Retinal fundus photograph.
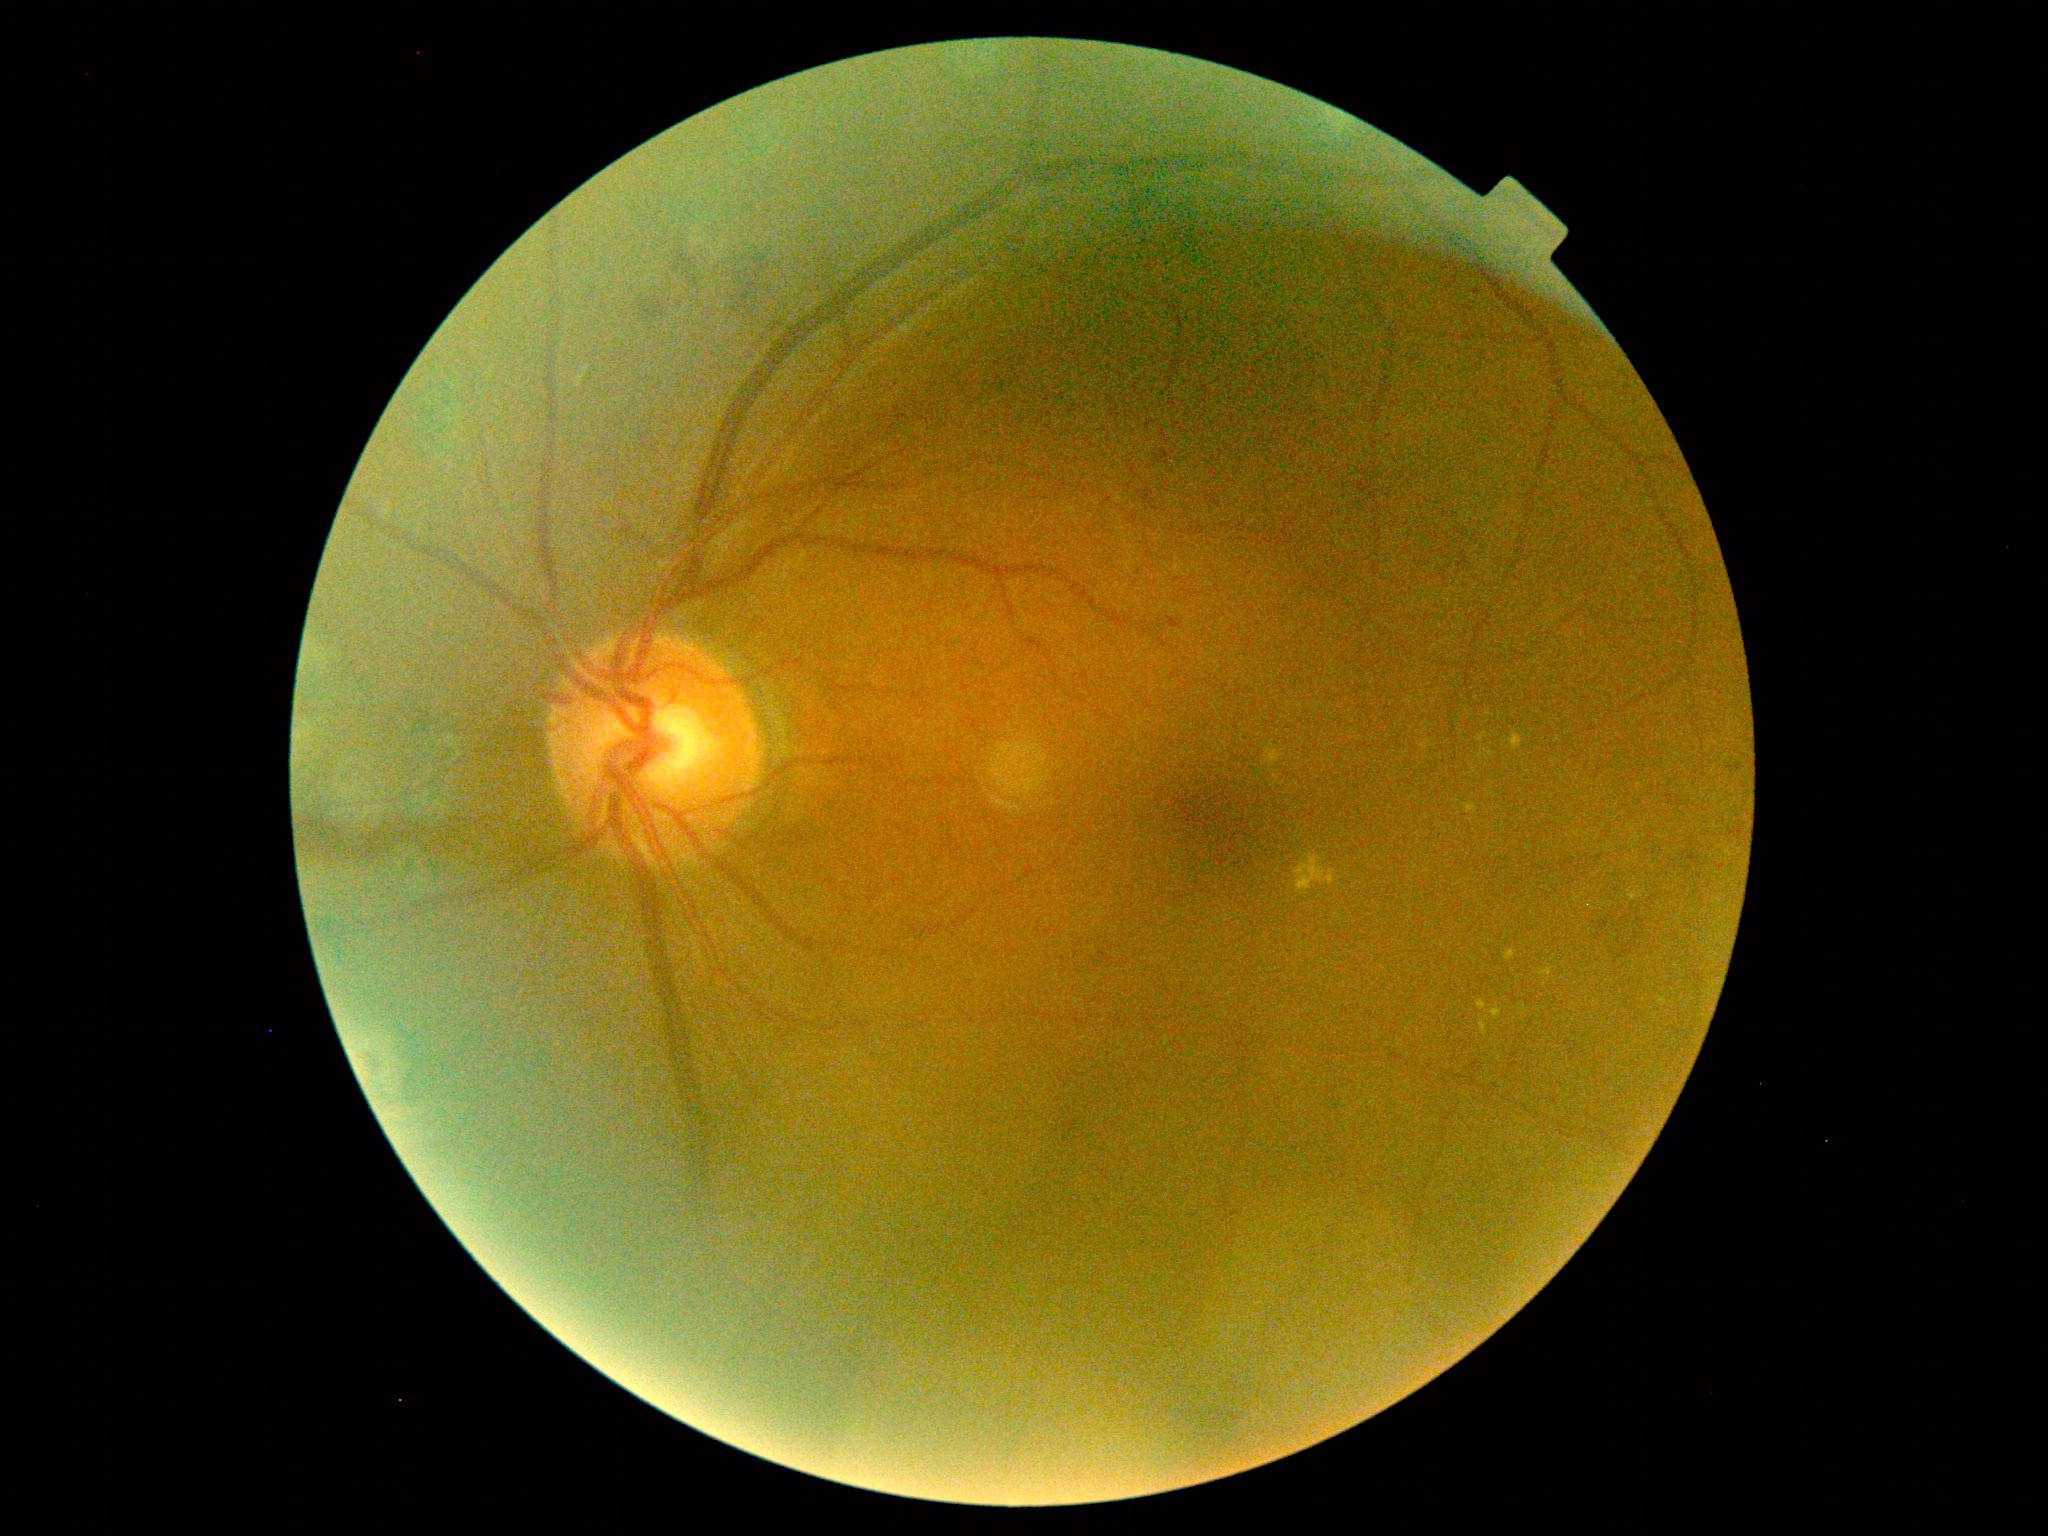 DR: grade 2 (moderate NPDR) — more than just microaneurysms but less than severe NPDR.